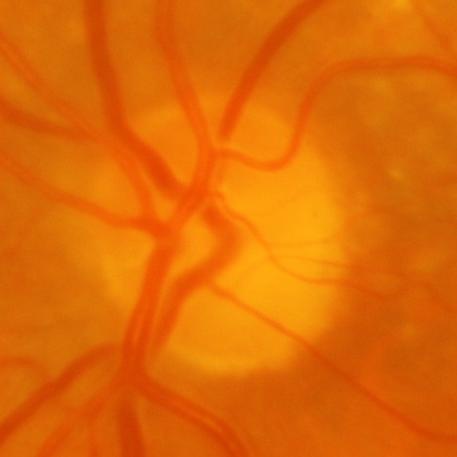
Findings consistent with glaucomatous changes.